Color fundus photograph — 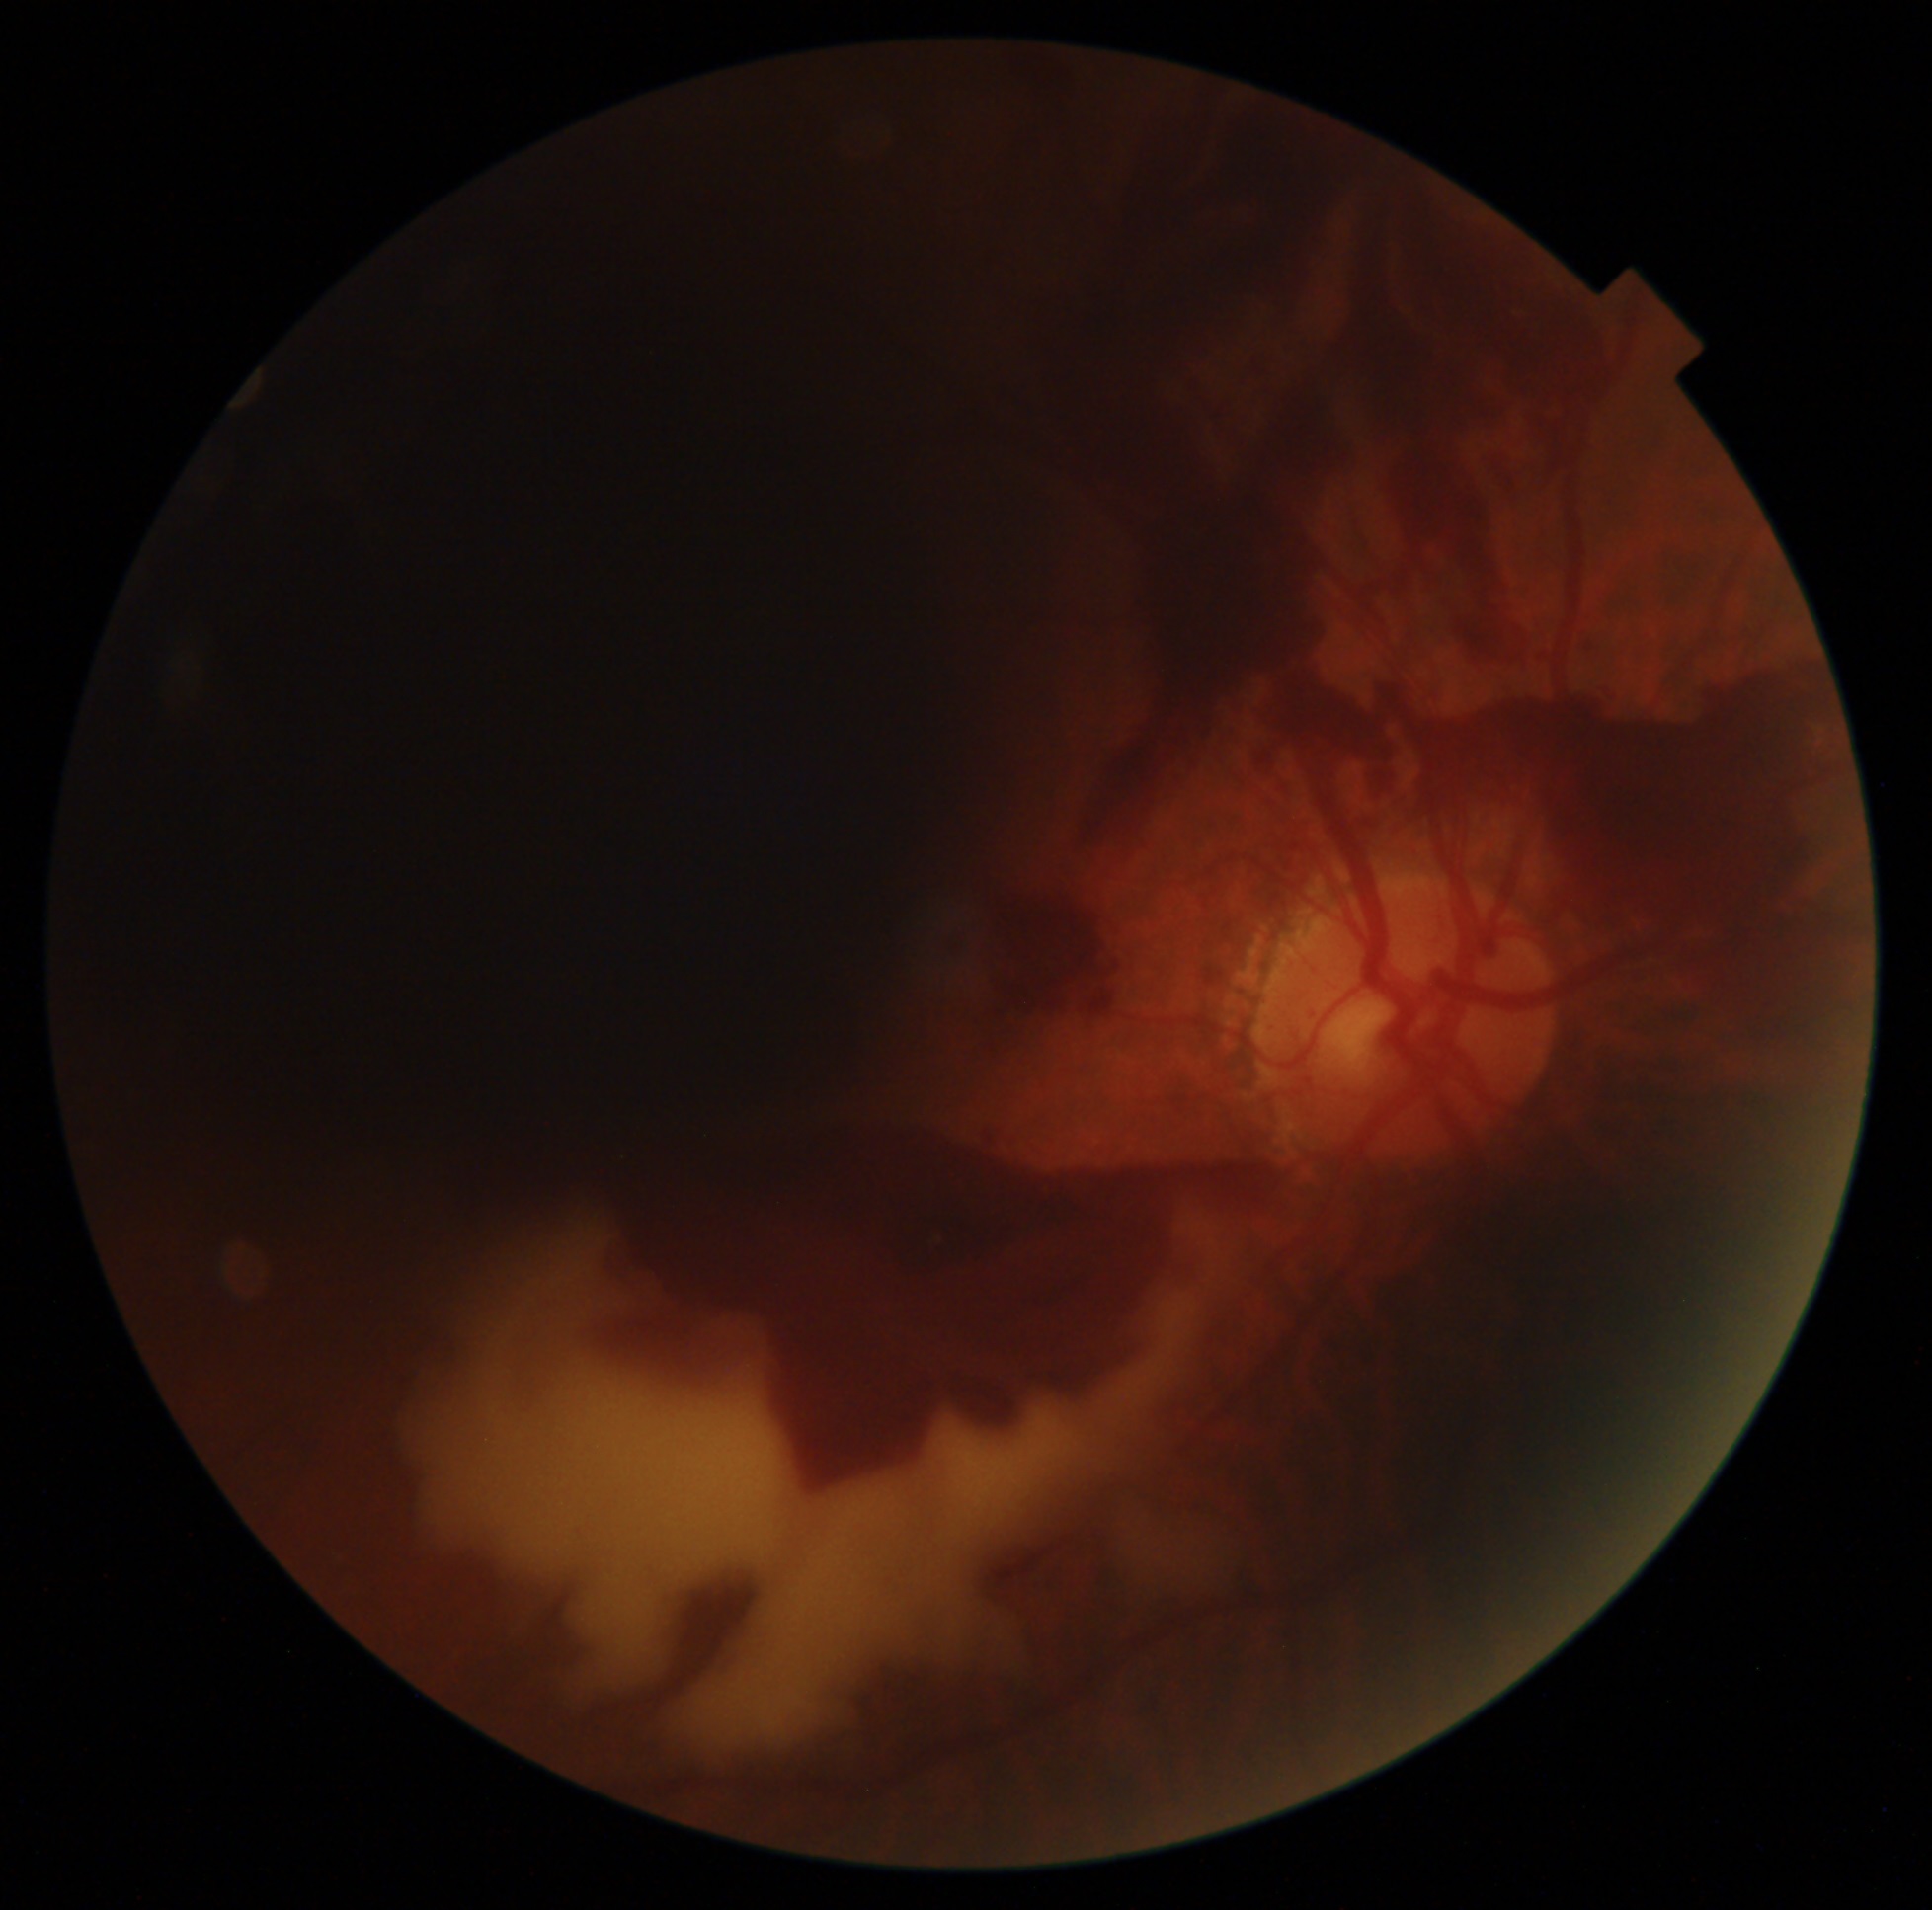

Disease class: proliferative diabetic retinopathy.
Diabetic retinopathy severity is 4.